Acquired with a NIDEK AFC-230 · nonmydriatic fundus photograph.
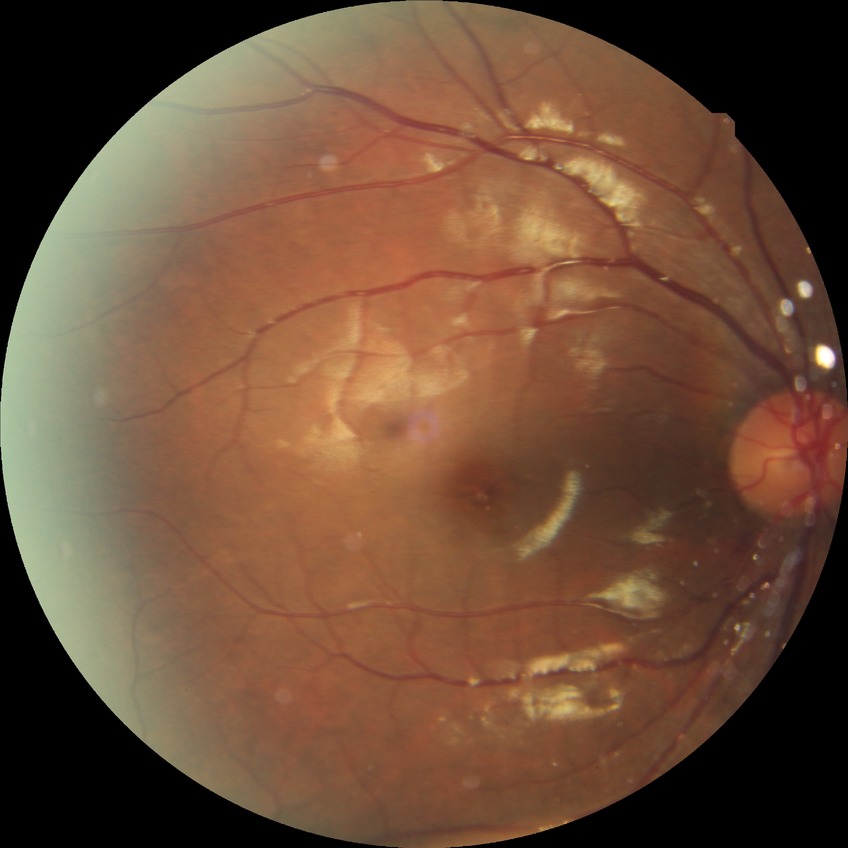
{
  "davis_grade": "SDR (simple diabetic retinopathy)"
}